Without pupil dilation; modified Davis grading; NIDEK AFC-230; retinal fundus photograph; 848 x 848 pixels.
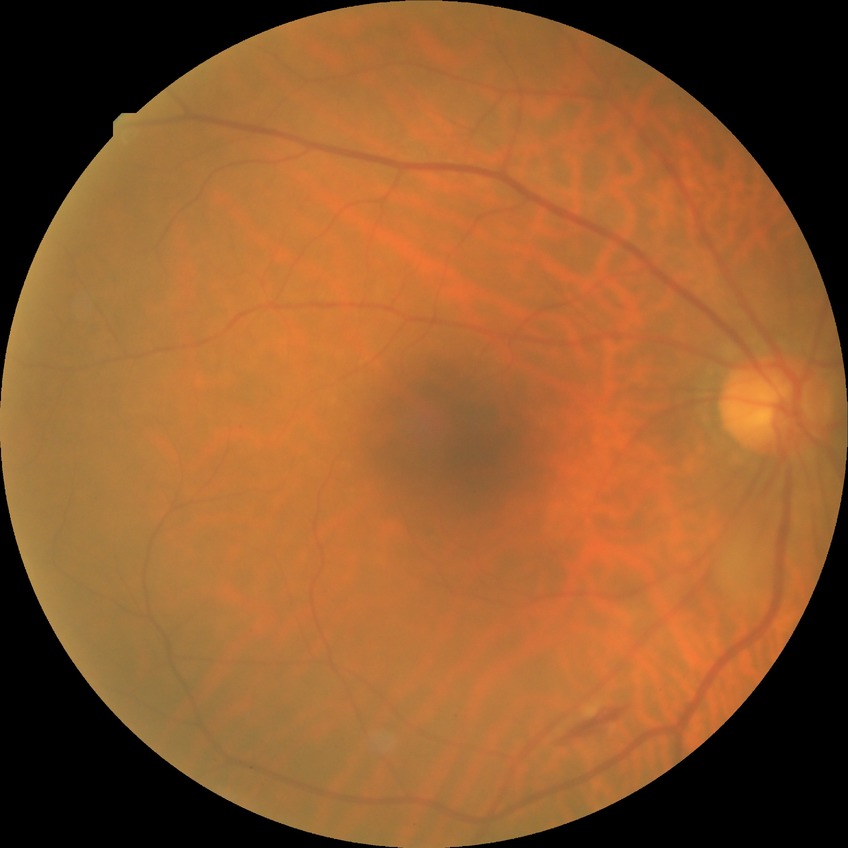
Diabetic retinopathy (DR): simple diabetic retinopathy (SDR).